Pediatric wide-field fundus photograph.
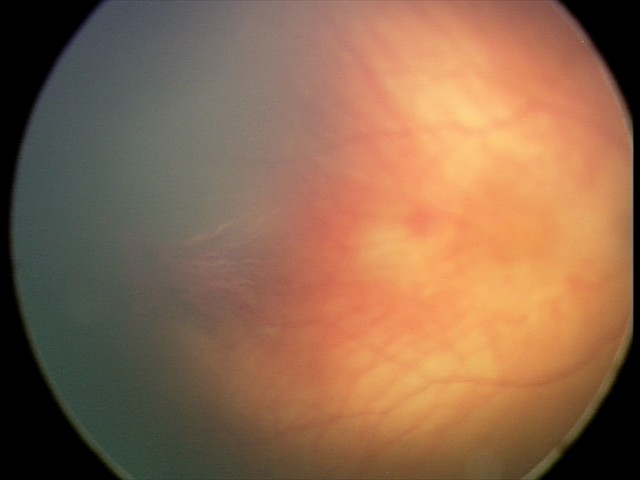
Diagnosis from this screening exam: retinal hemorrhages.